CFP; image size 2352x1568:
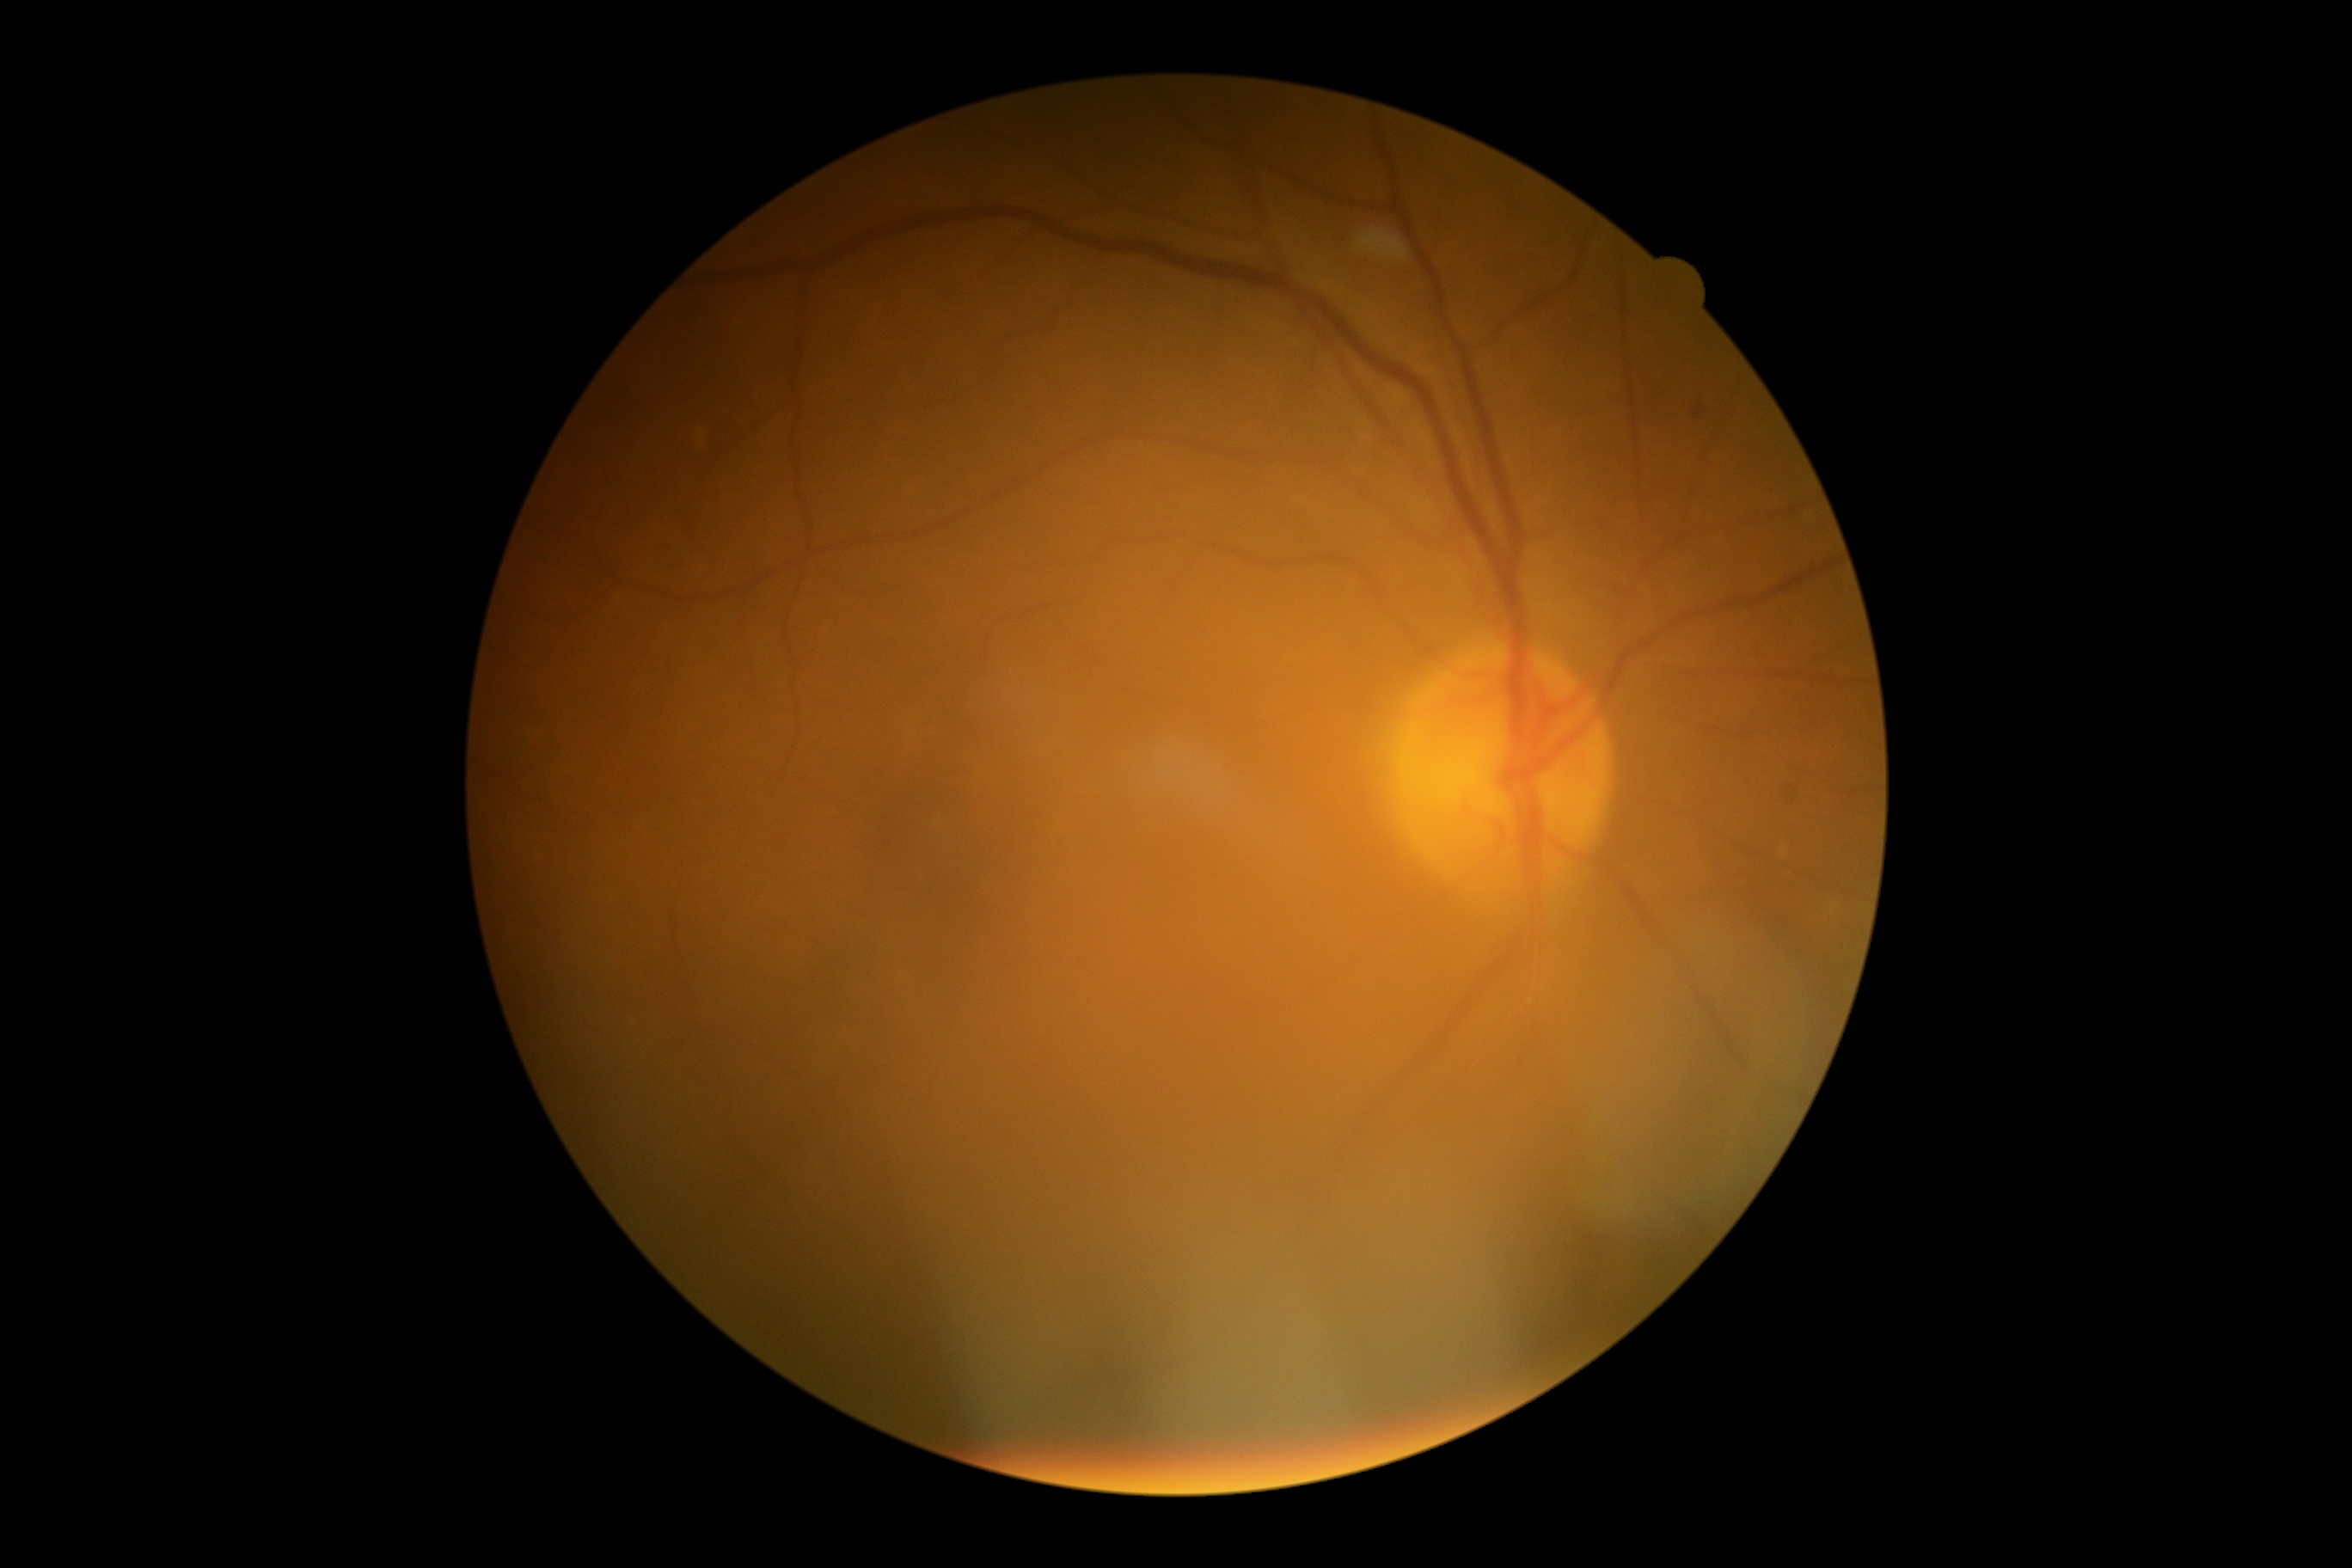 Diabetic retinopathy grade is 2/4. DR class: non-proliferative diabetic retinopathy.